Color fundus photograph — 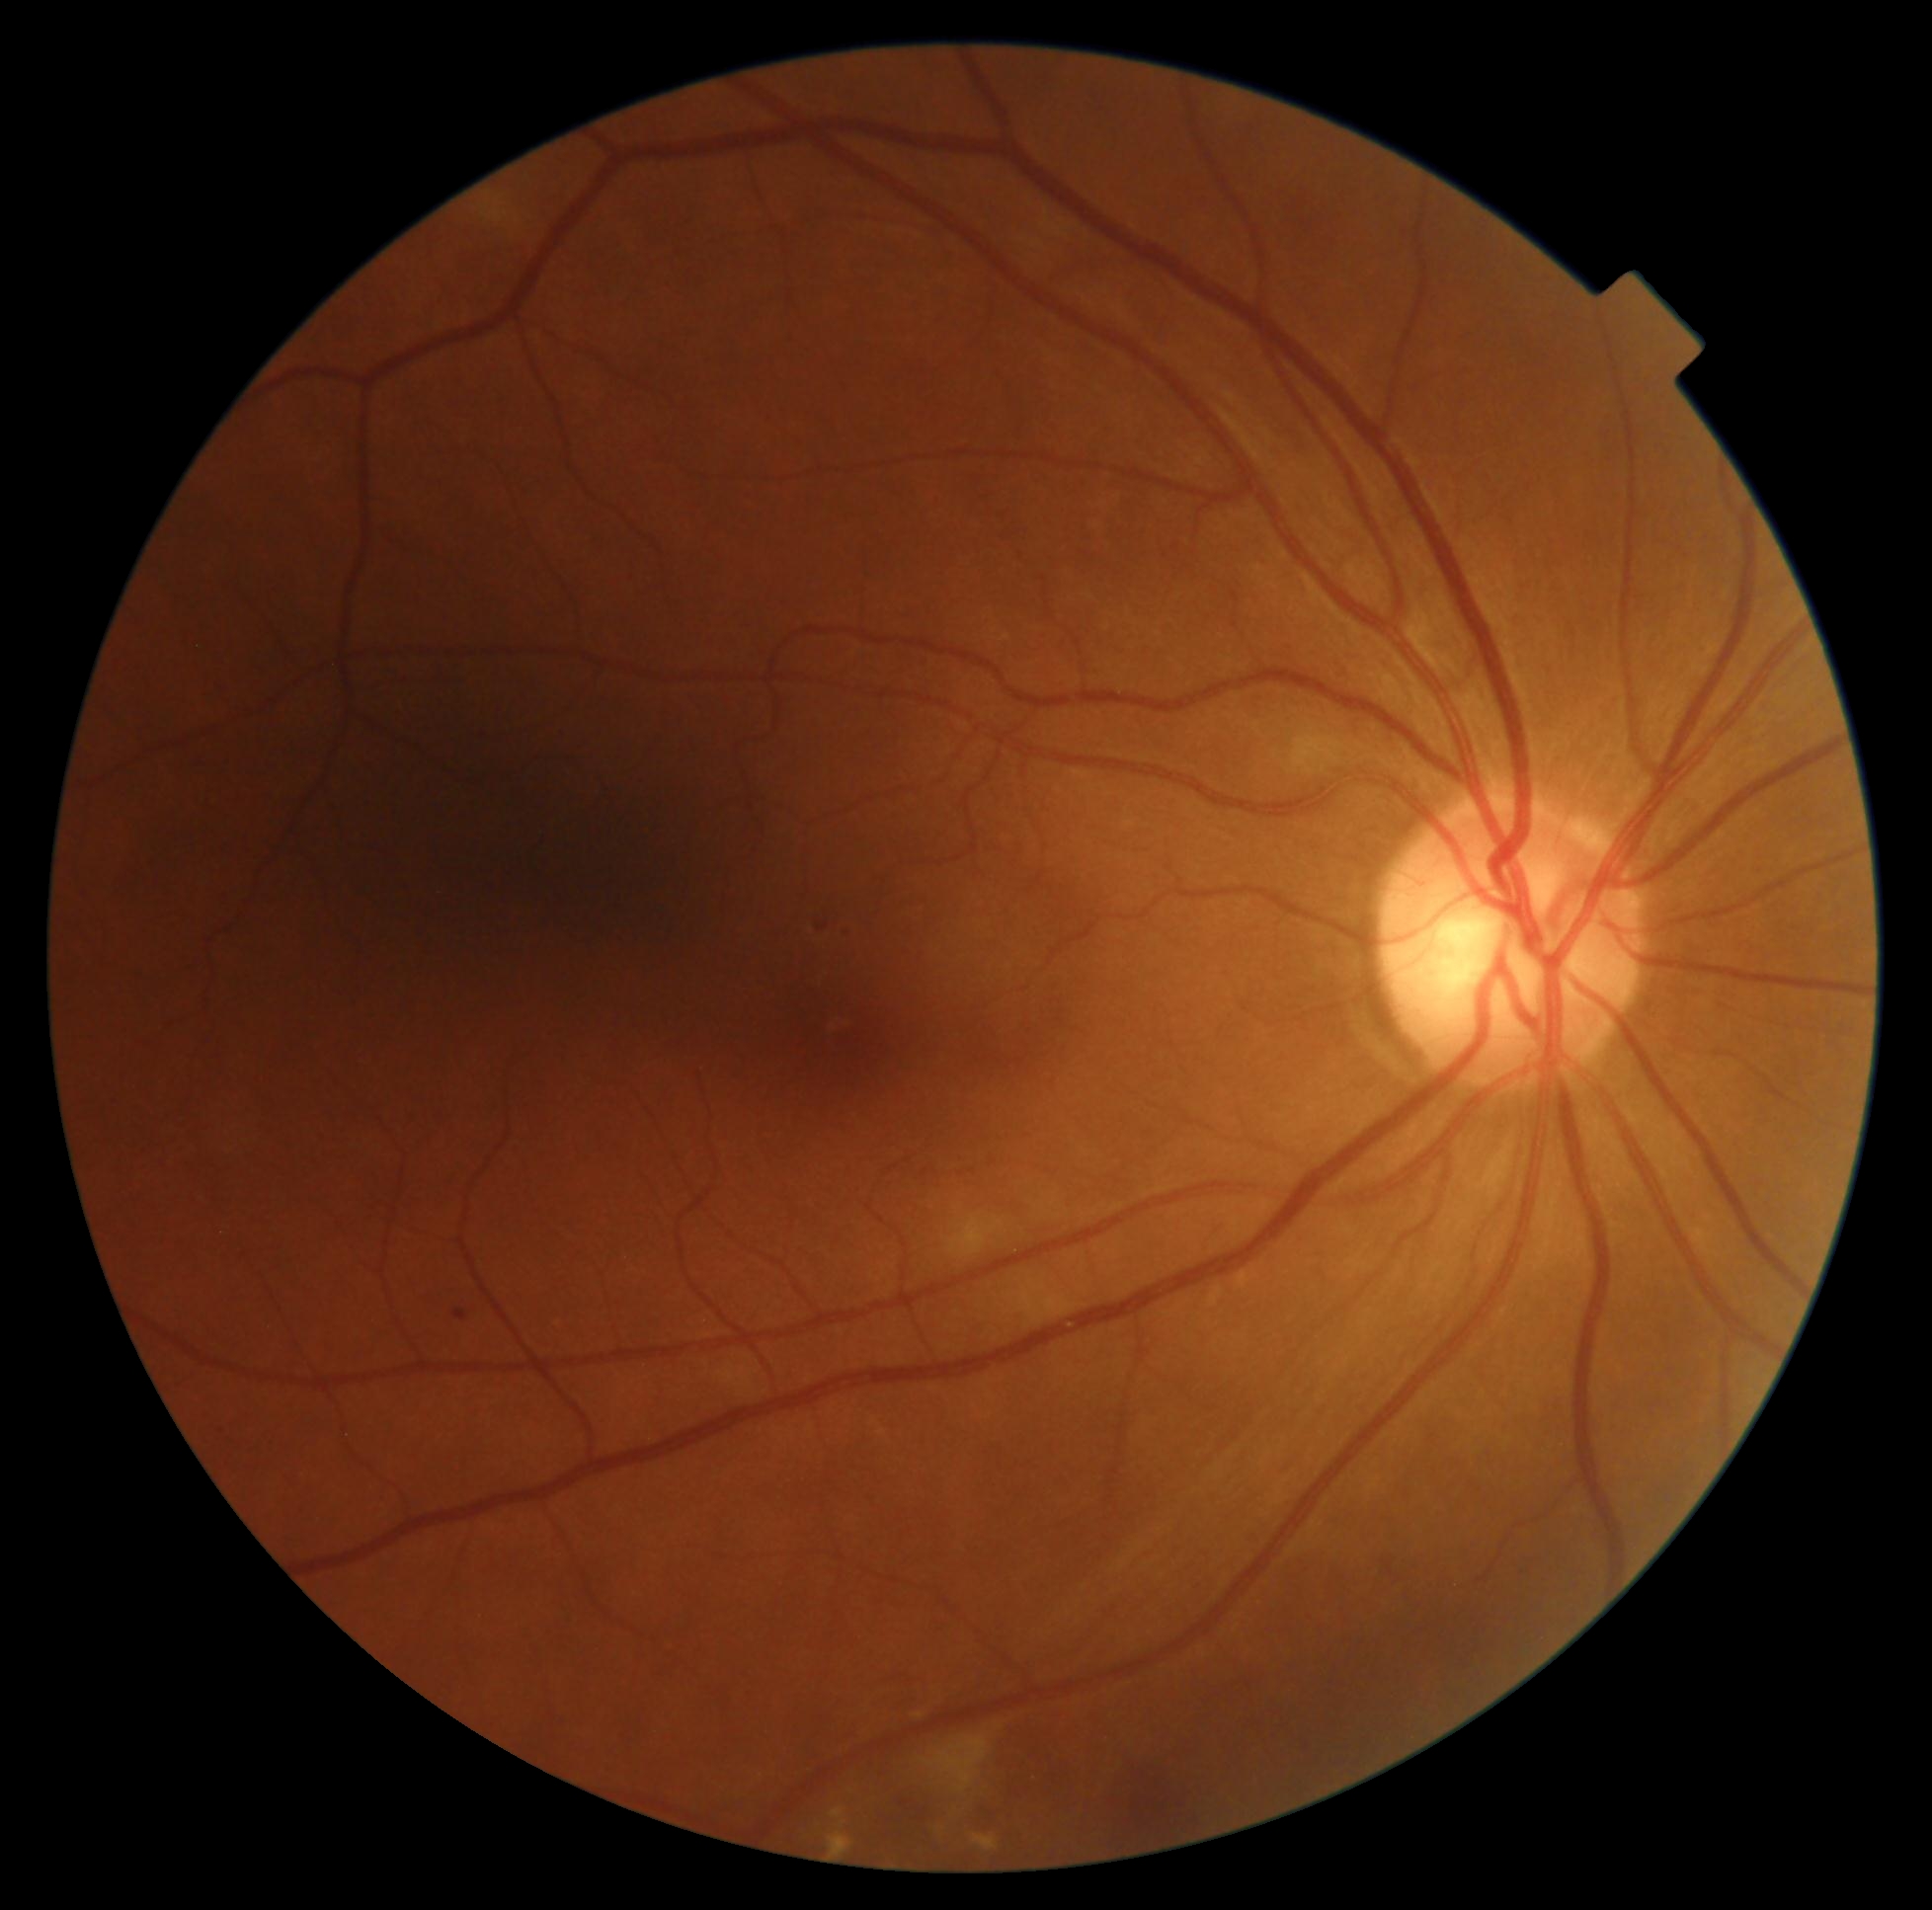

DR severity: grade 2.